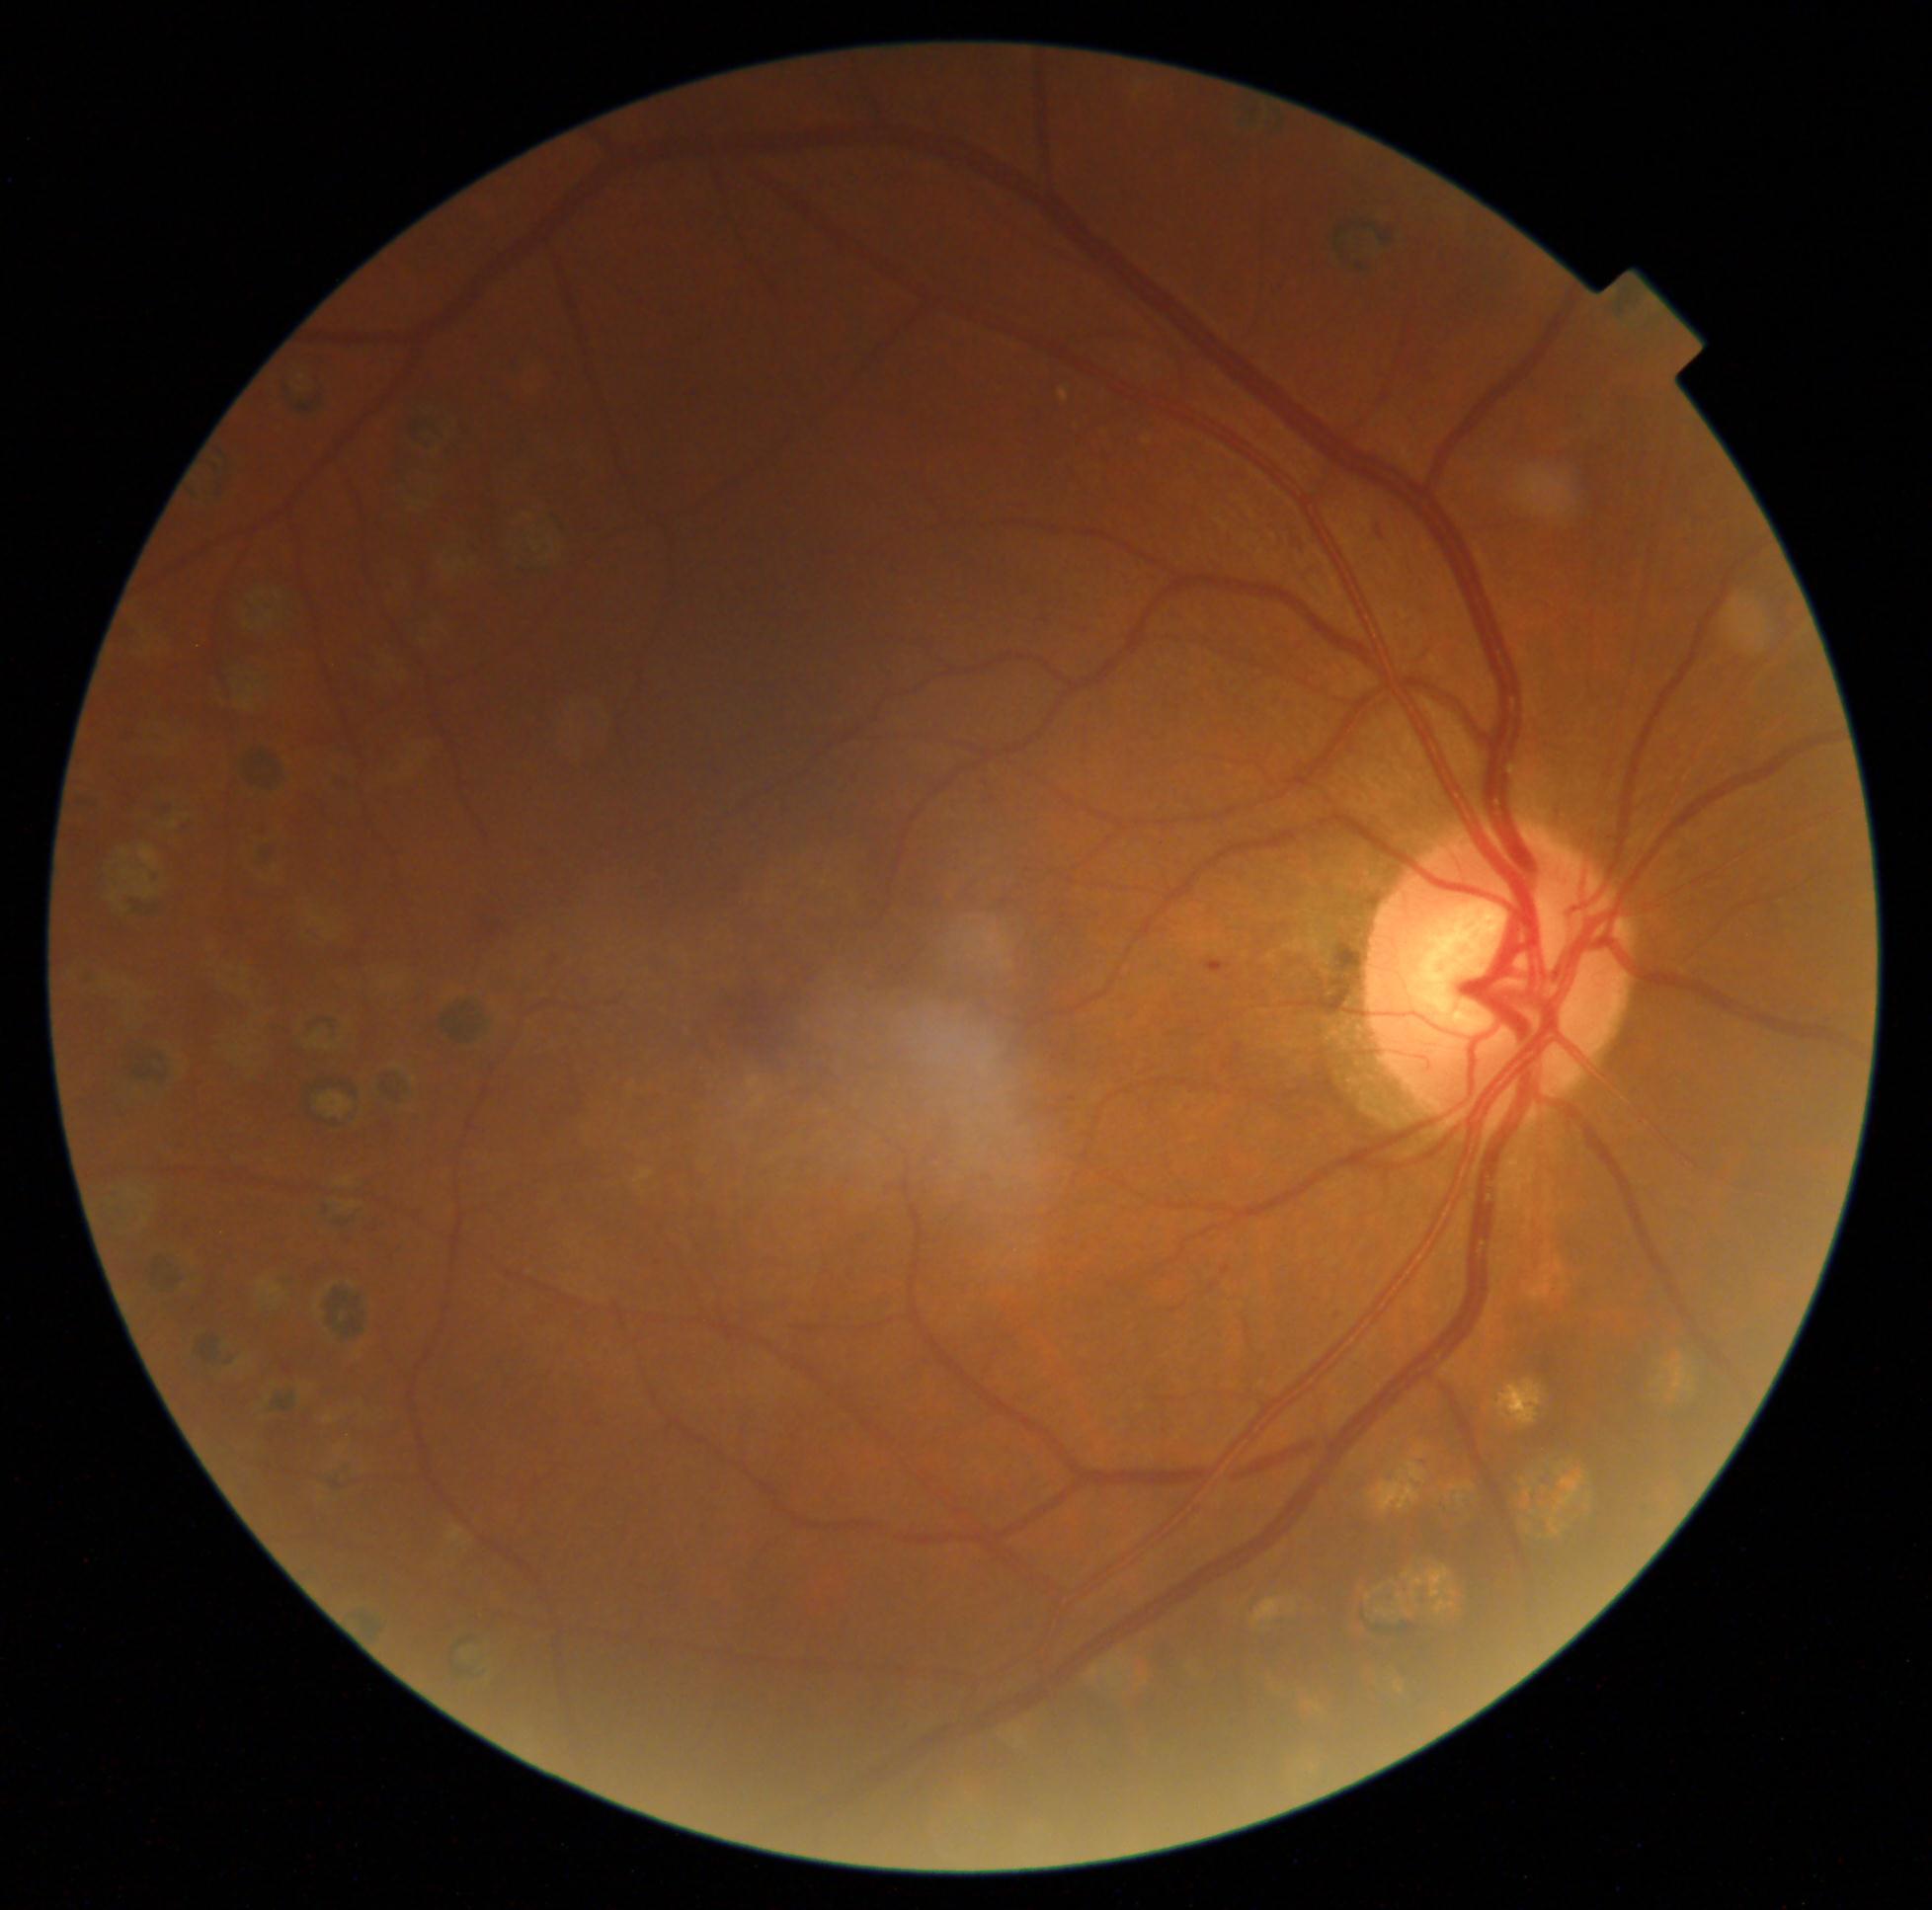
Retinopathy is grade 2.